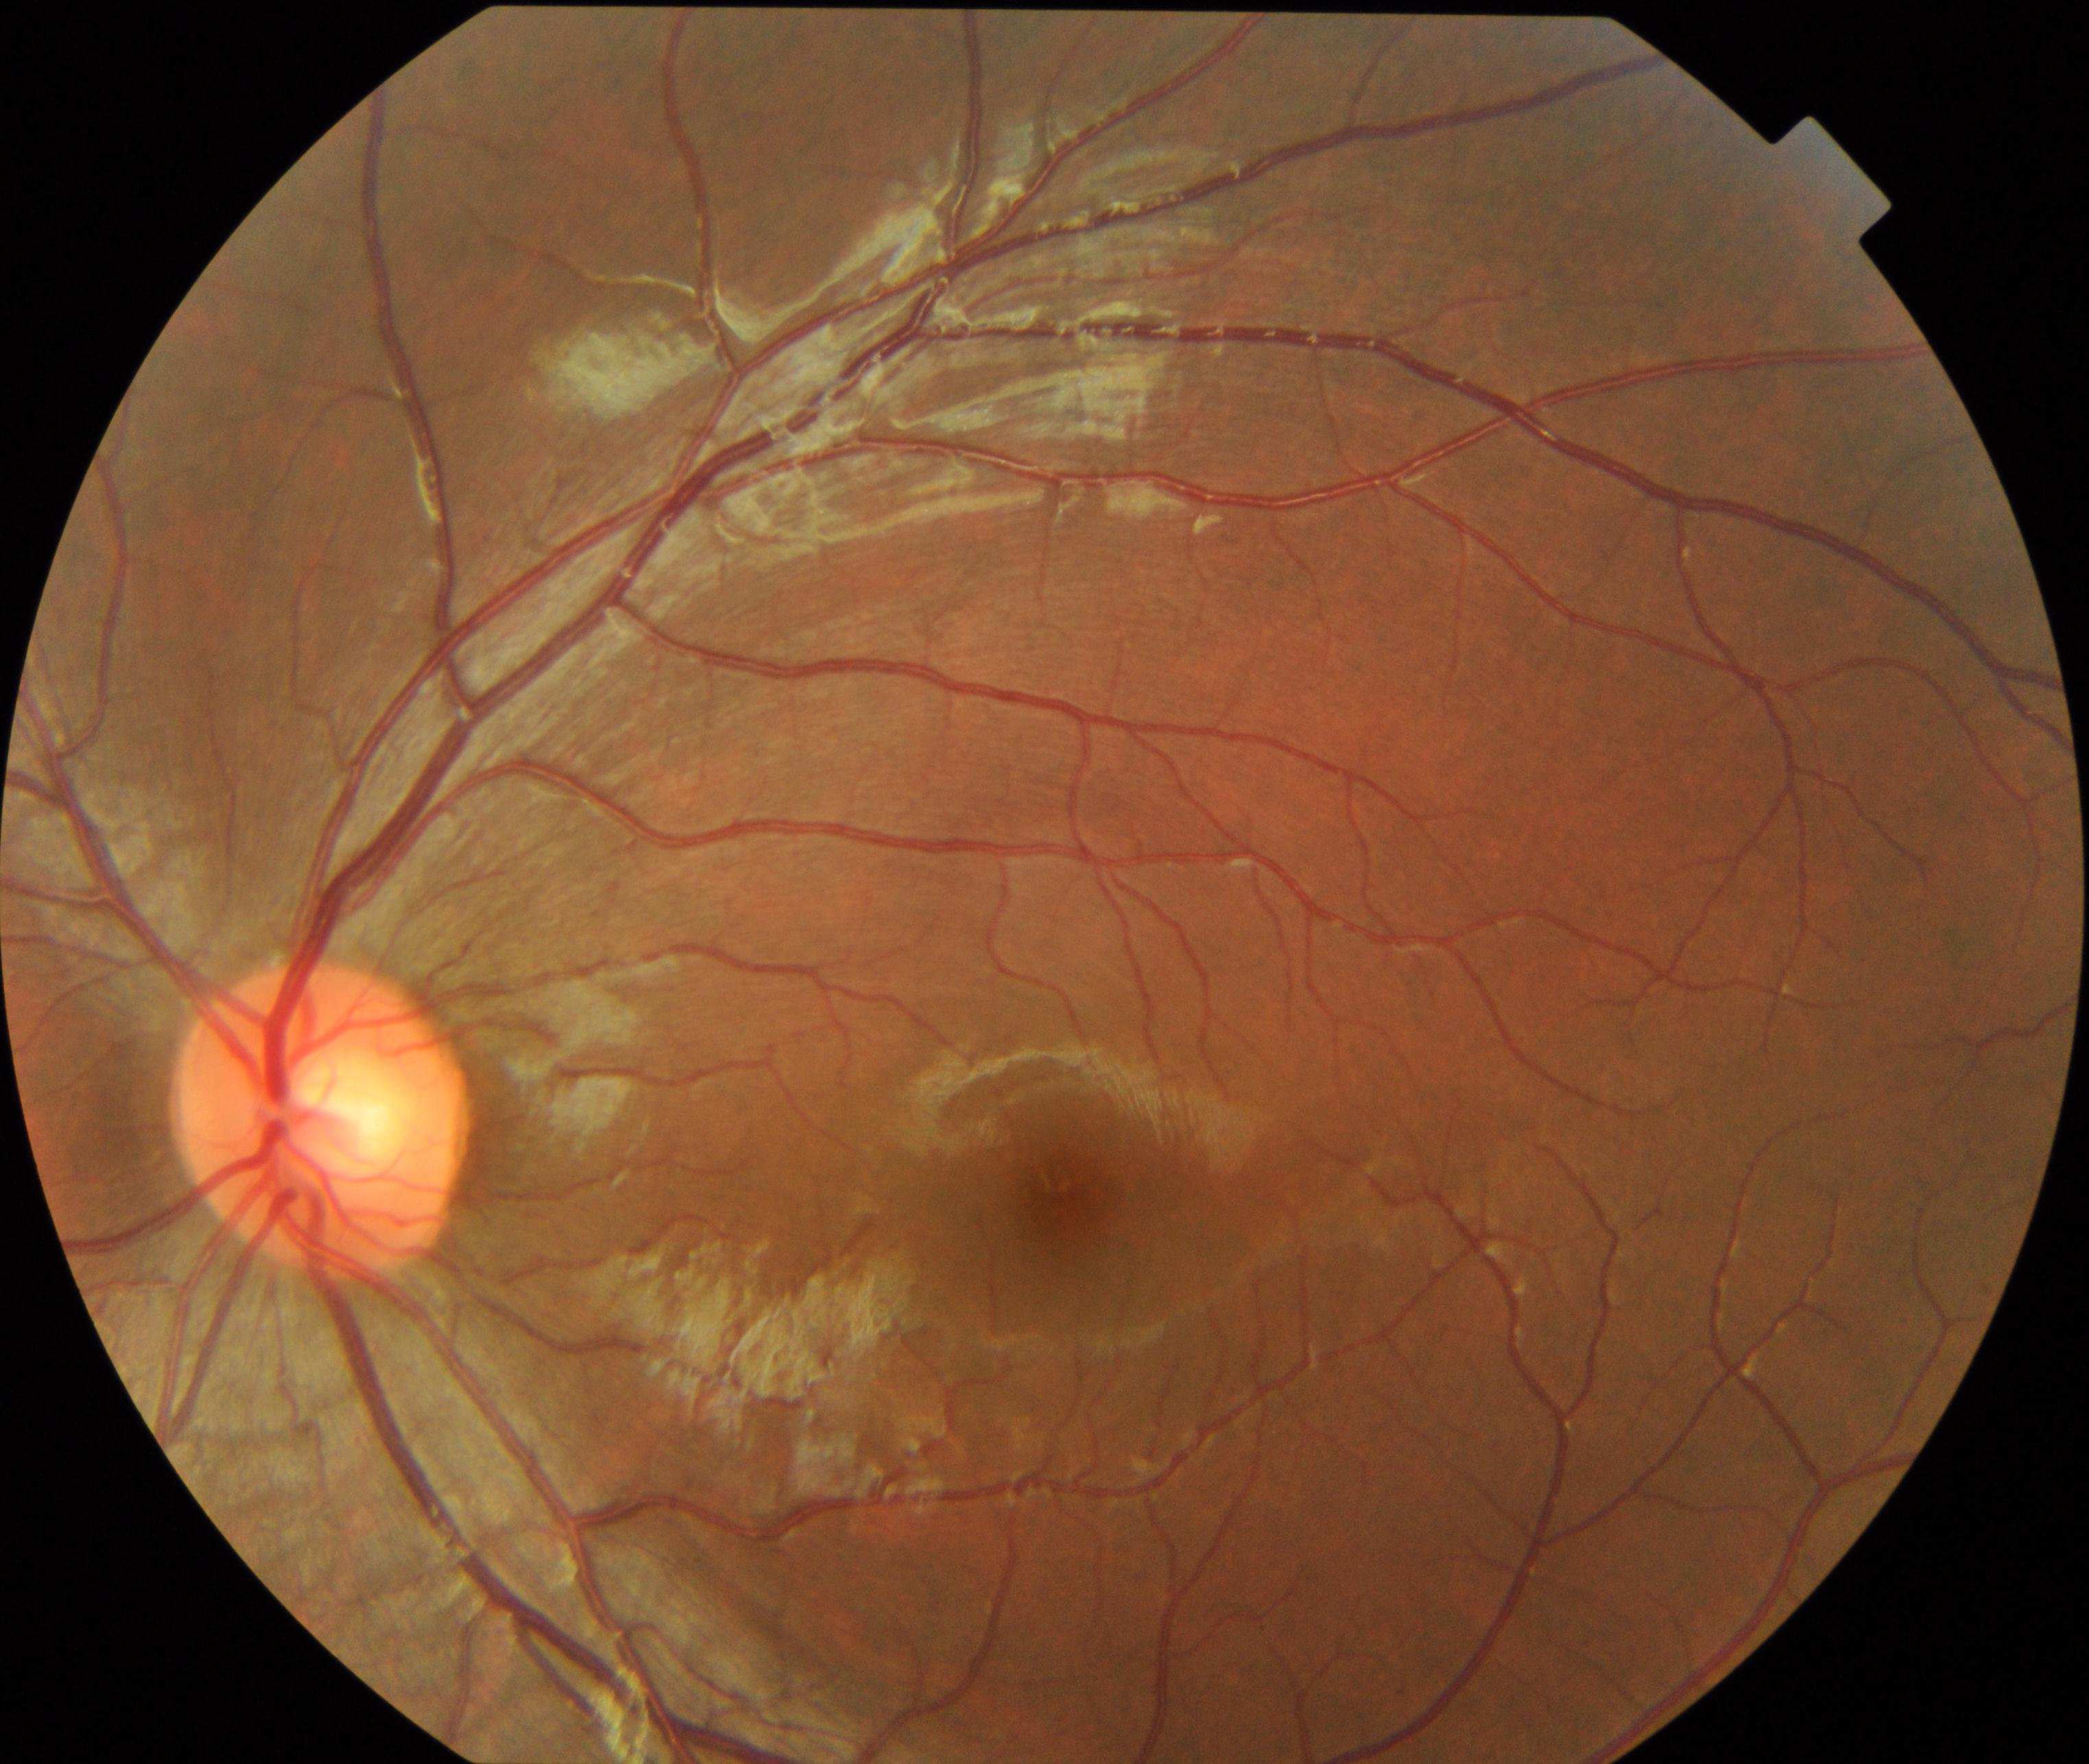 Impression: normal fundus.